Camera: NIDEK AFC-230, 848 x 848 pixels
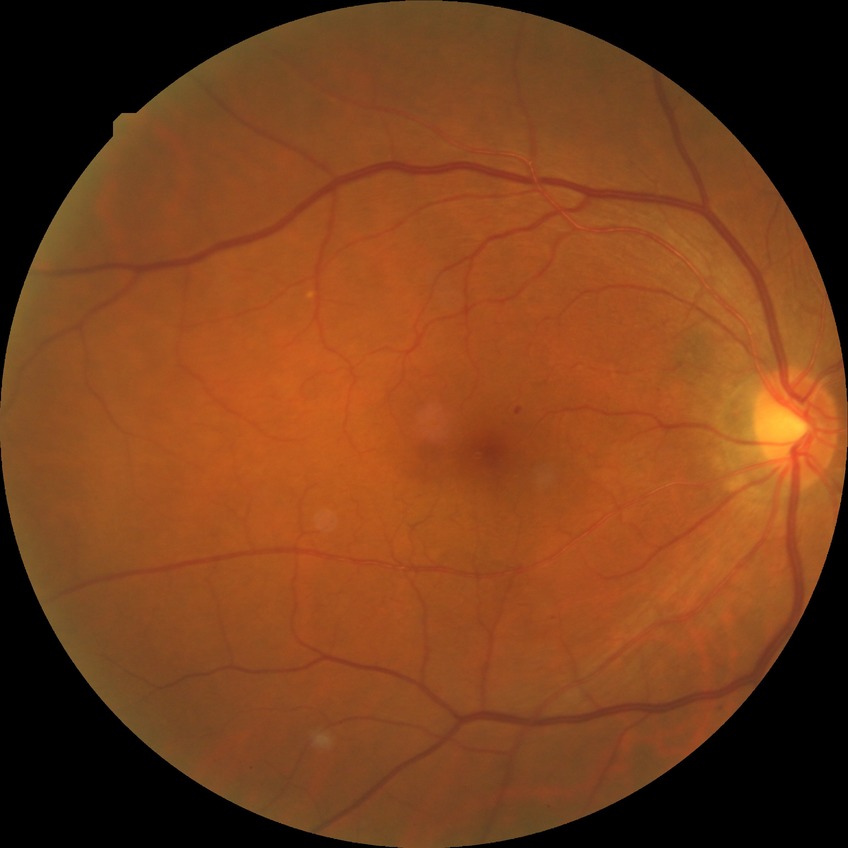   davis_grade: simple diabetic retinopathy
  proliferative_class: non-proliferative diabetic retinopathy